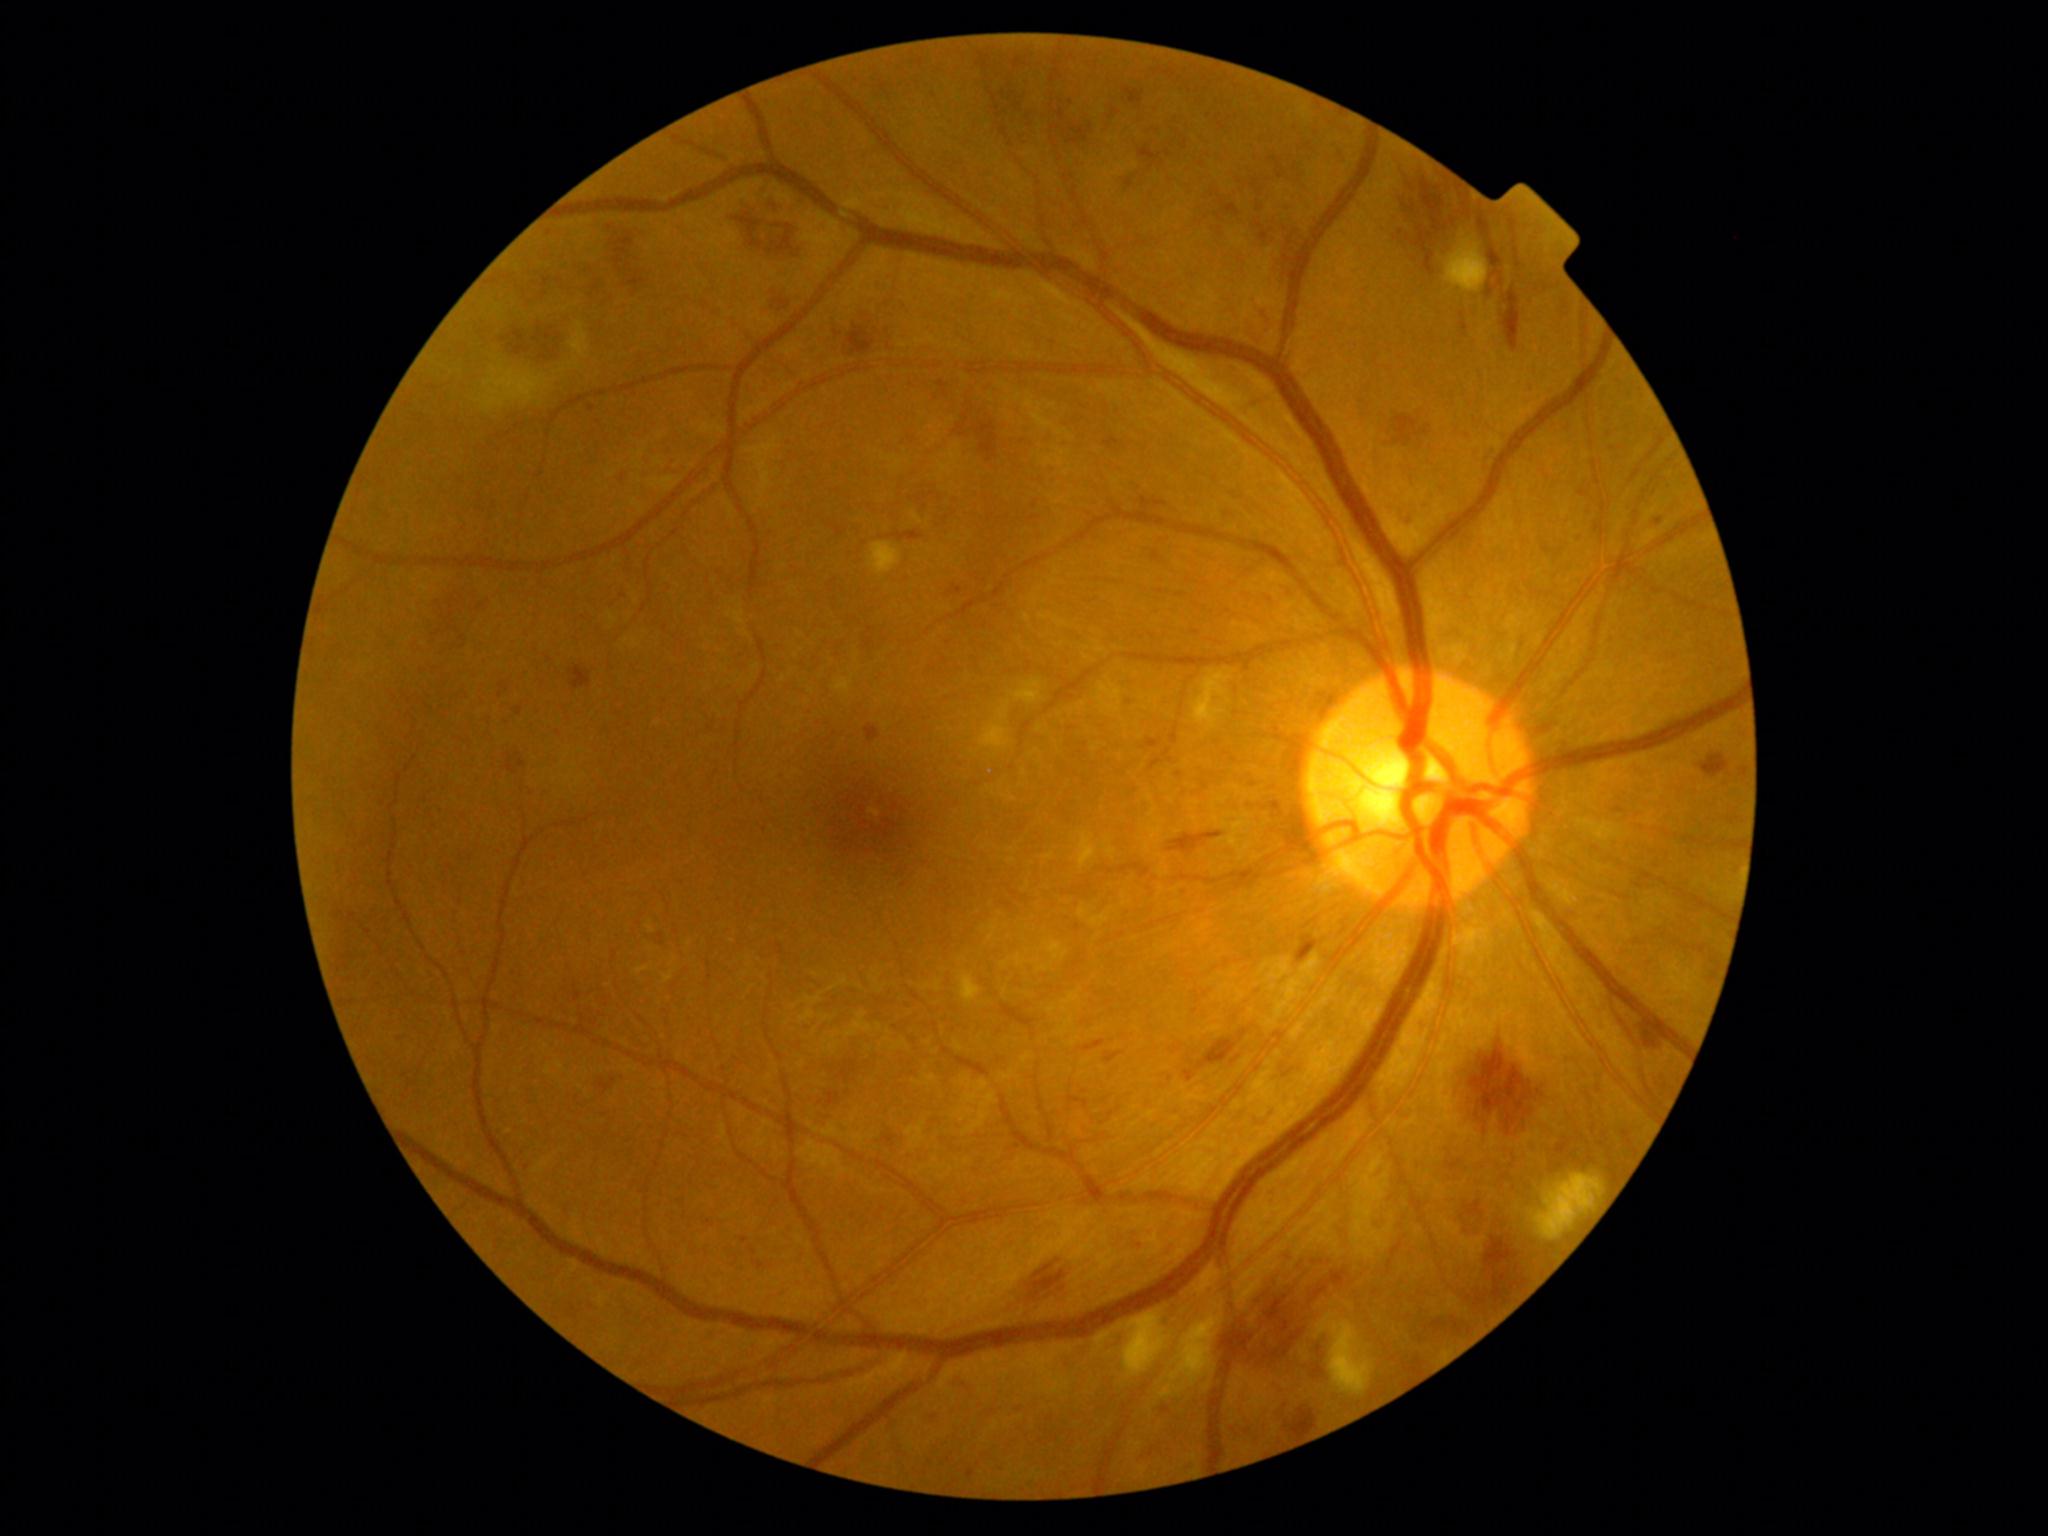 Diabetic retinopathy (DR) is 2 — more than just microaneurysms but less than severe NPDR.